2352x1568px. 45° field of view: 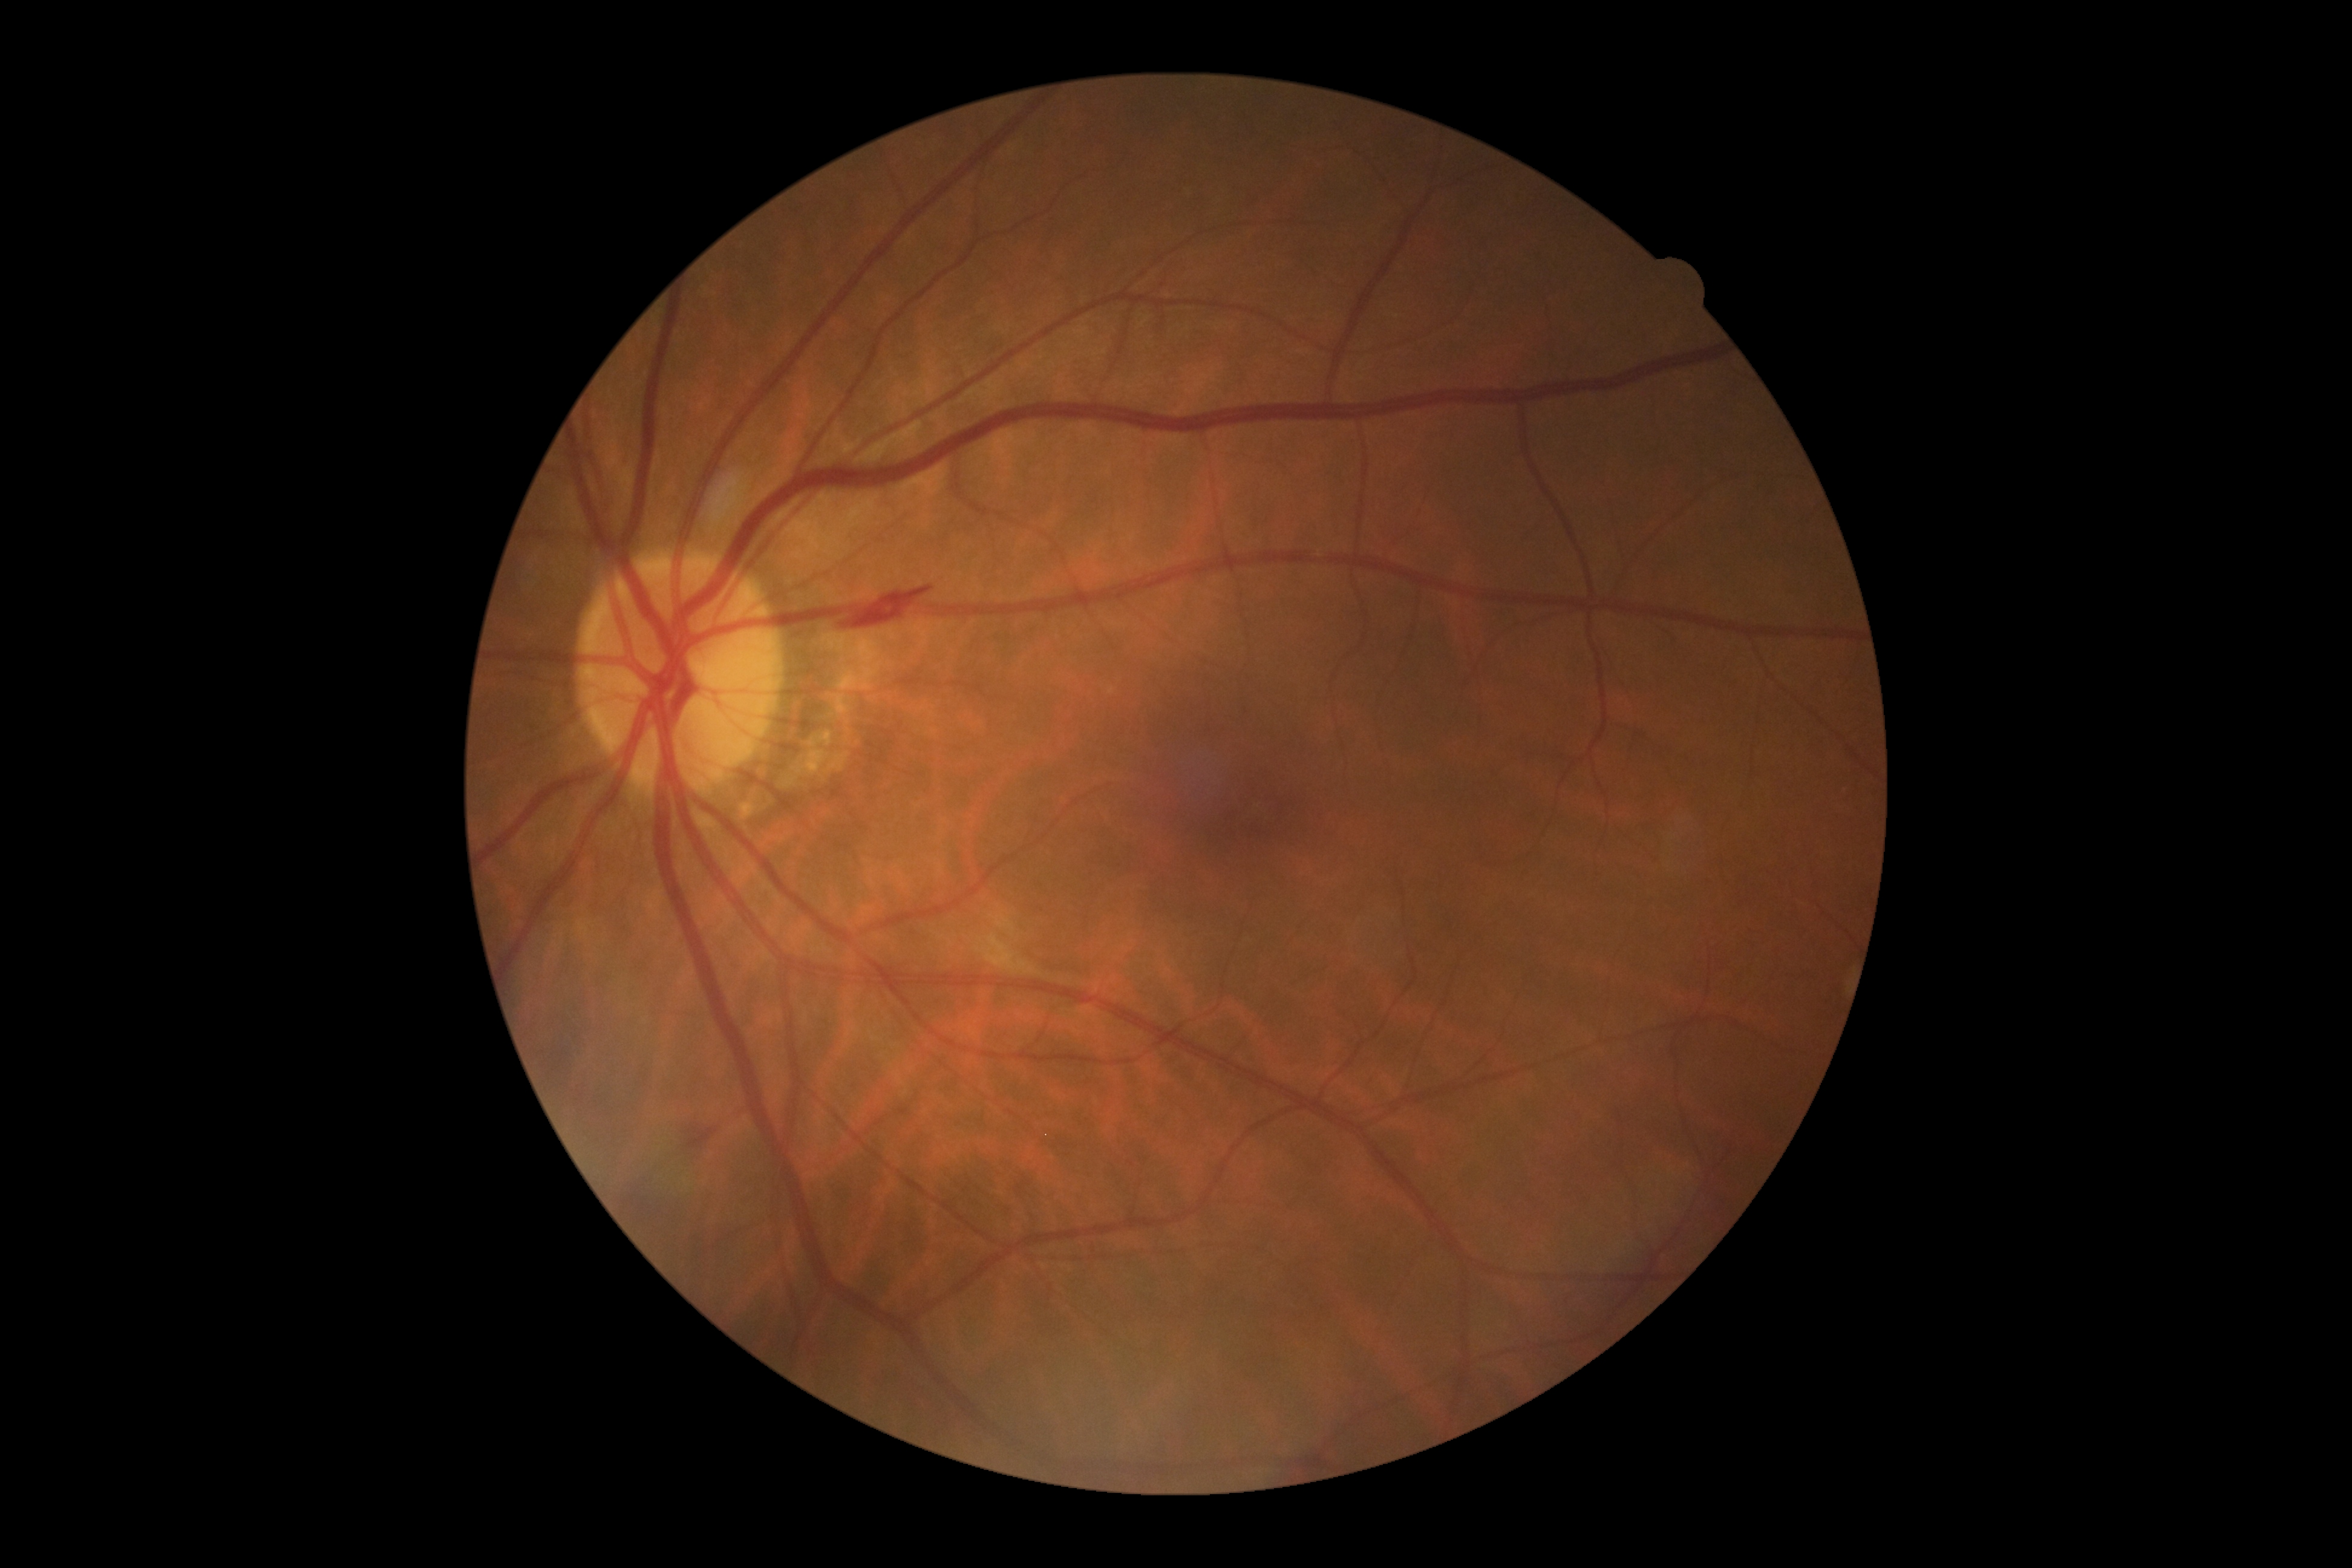 dr_grade: grade 2